848x848px, retinal fundus photograph:
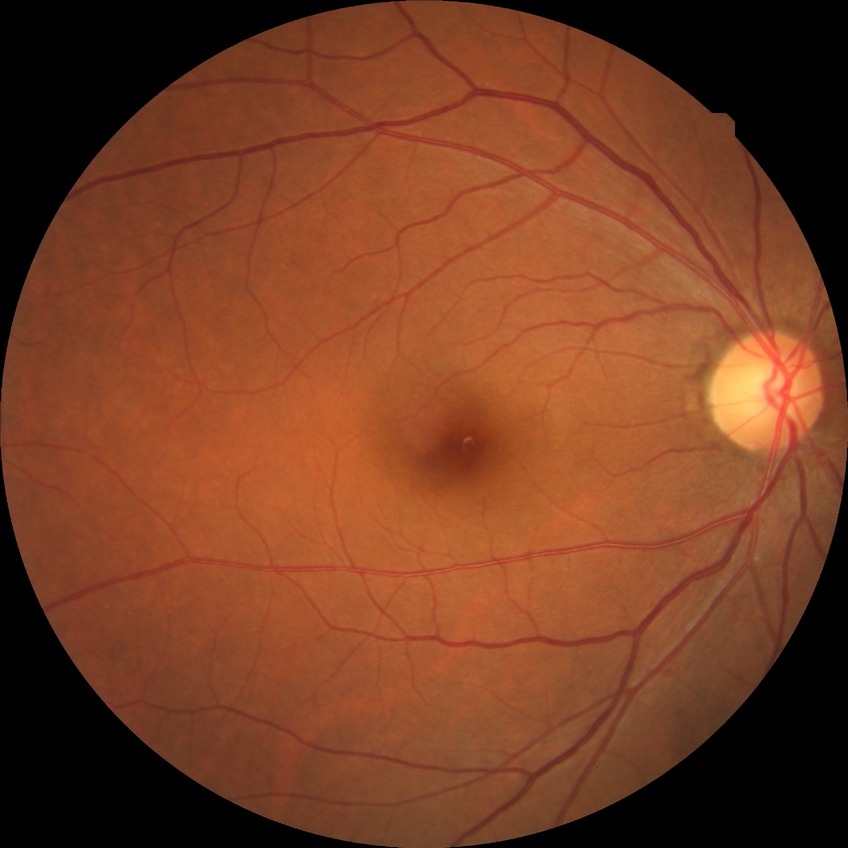

{
  "davis_grade": "no diabetic retinopathy"
}